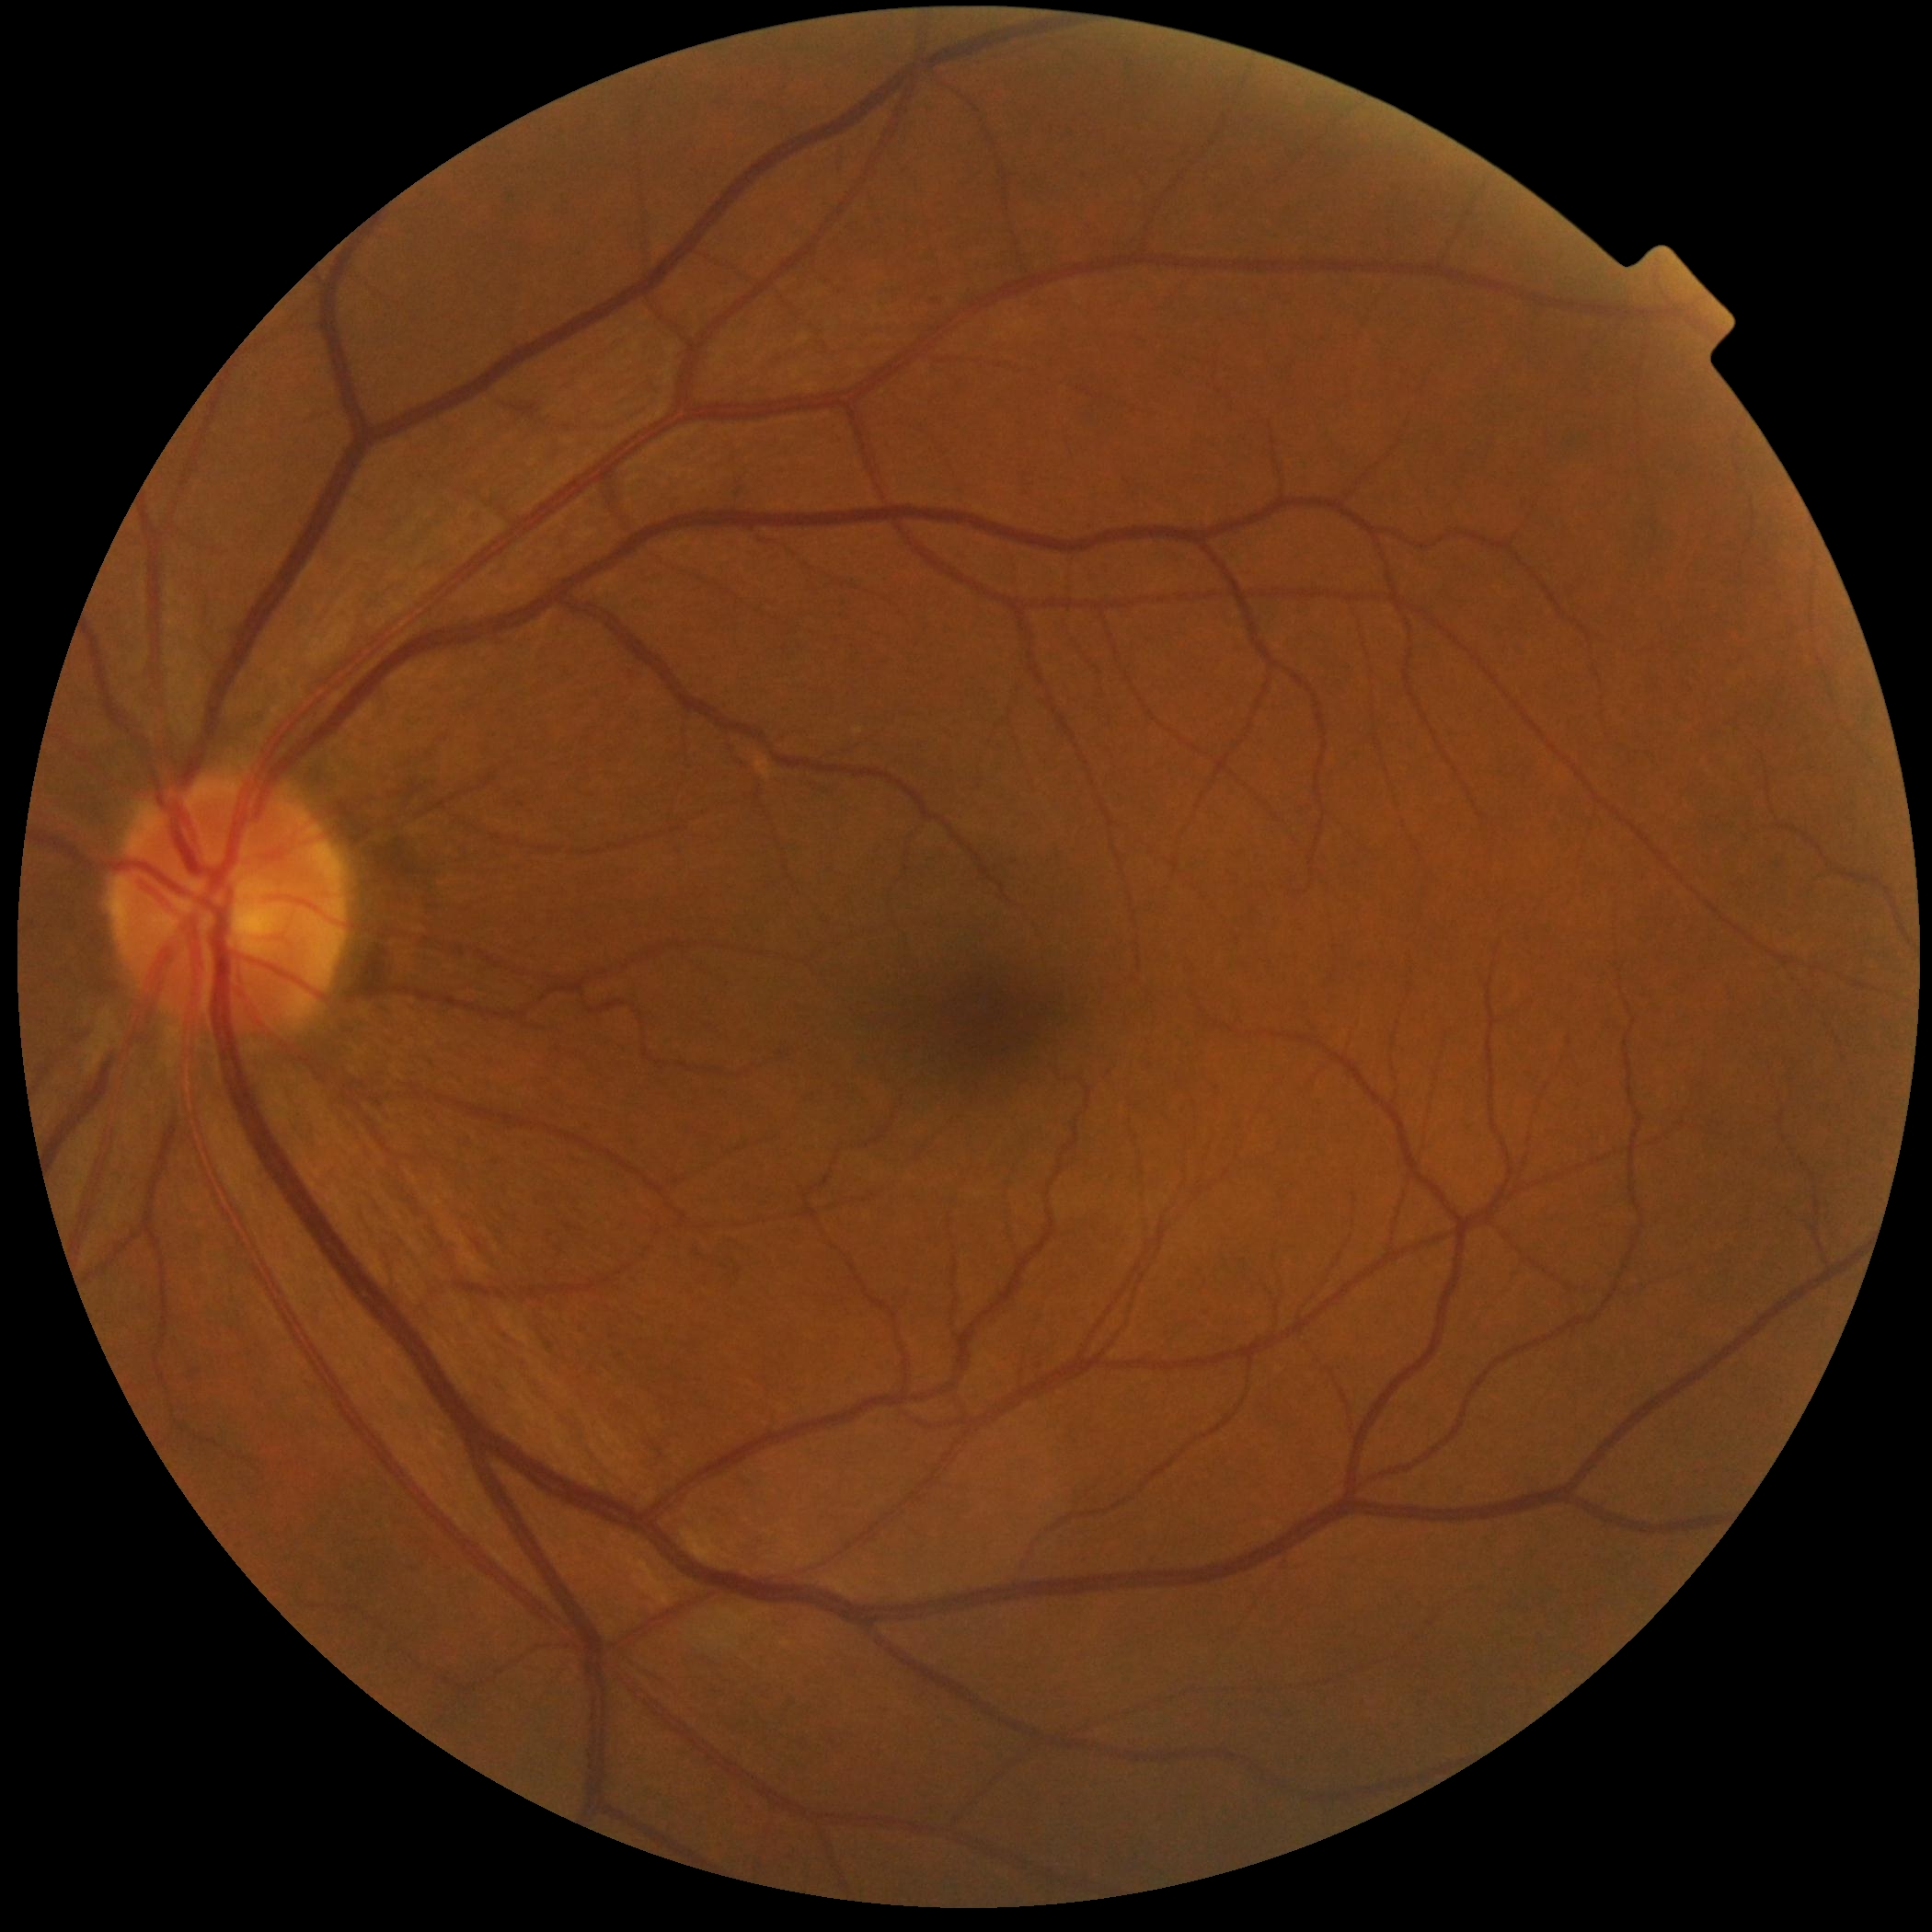 retinopathy: grade 0 (no apparent retinopathy).